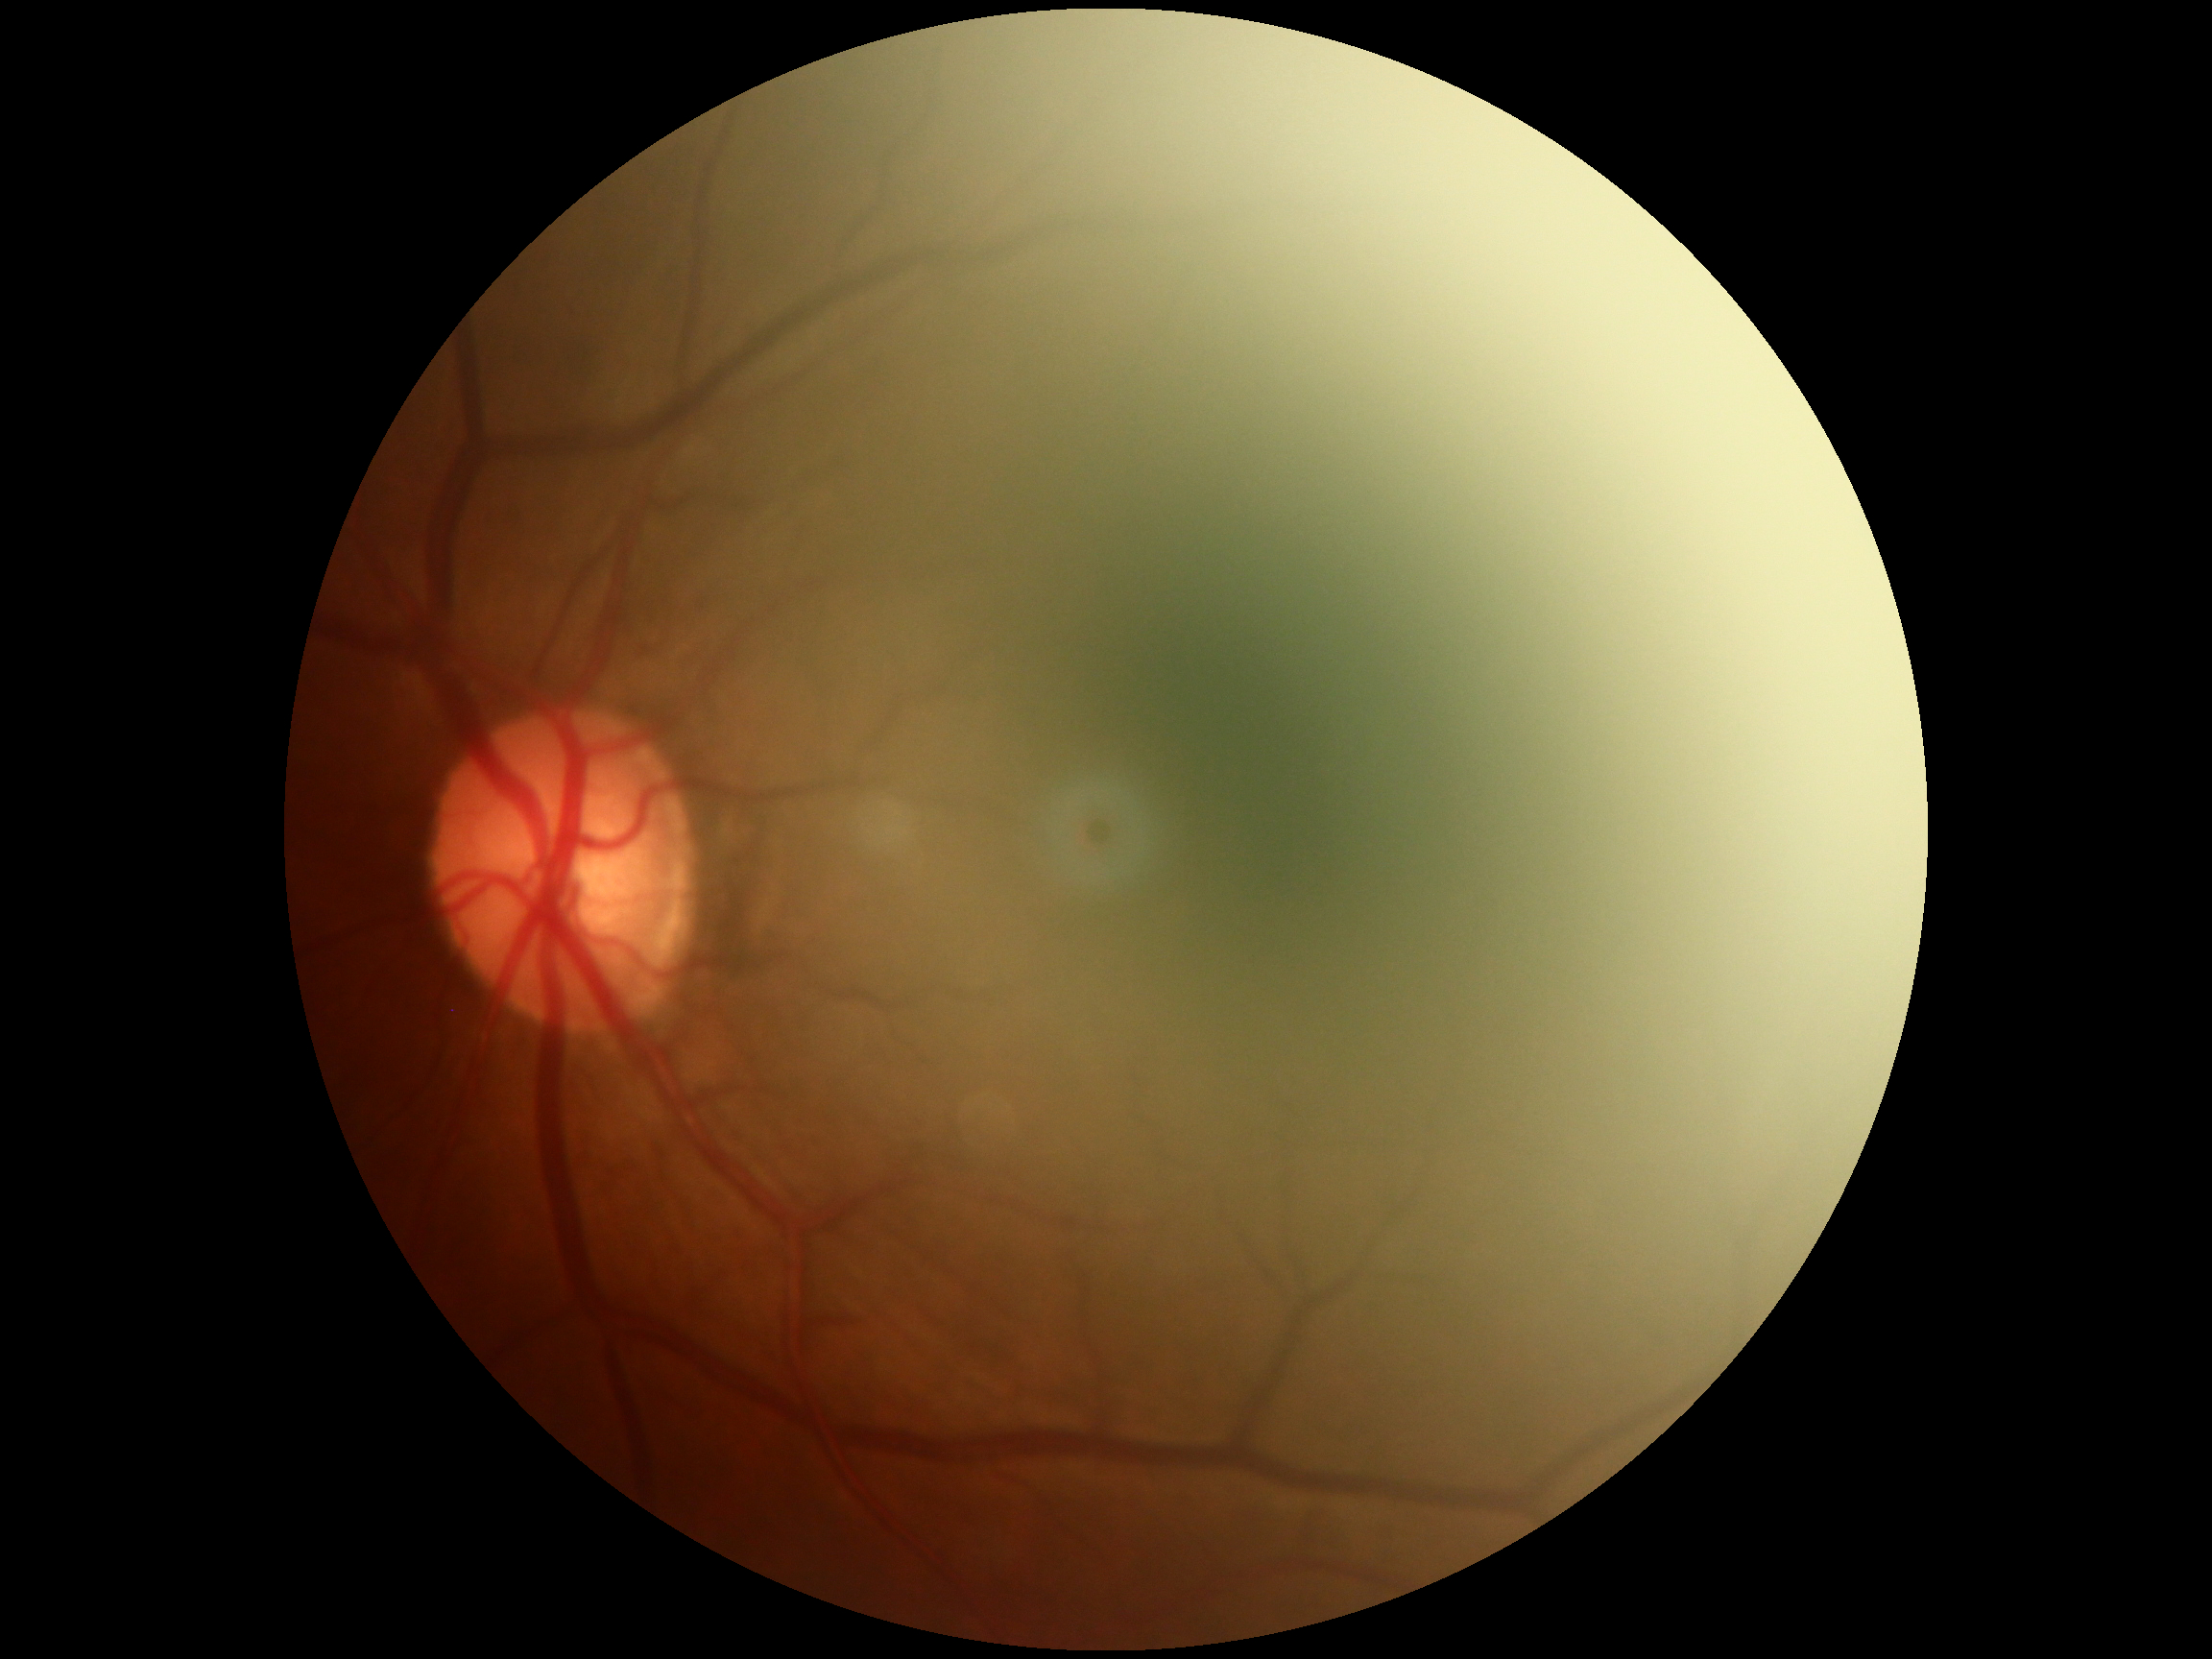
No signs of diabetic retinopathy.
Diabetic retinopathy severity is no apparent diabetic retinopathy (grade 0).